100° field of view (Phoenix ICON) · wide-field contact fundus photograph of an infant — 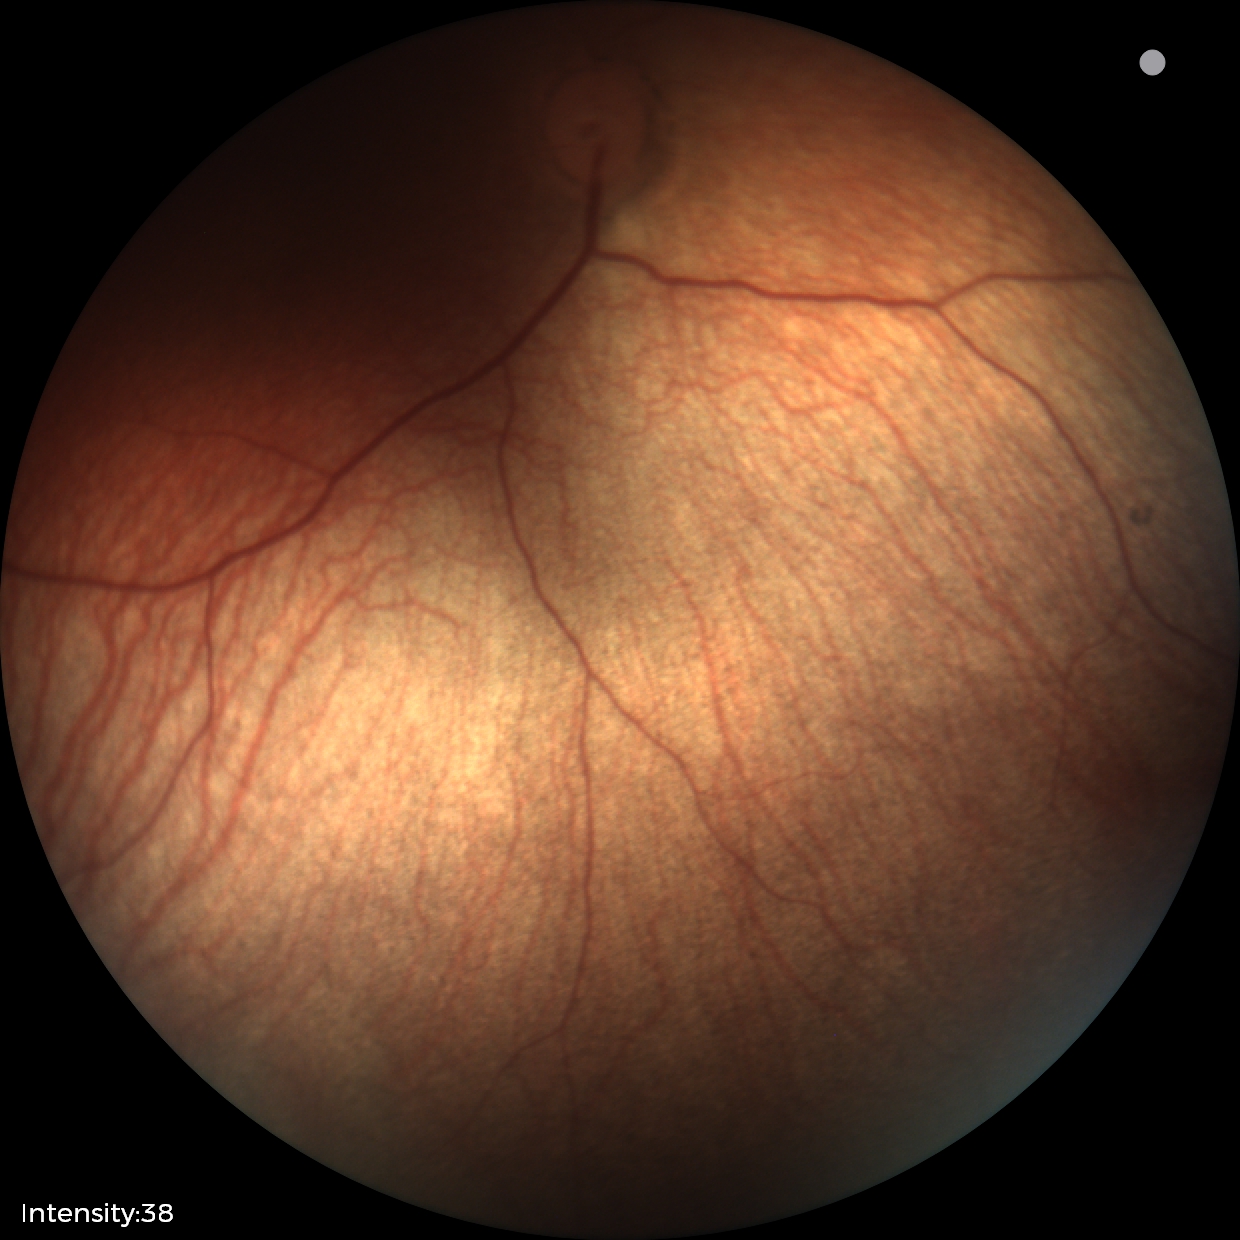

Screening examination diagnosed as physiological.